45-degree field of view. 2048 by 1536 pixels. CFP: 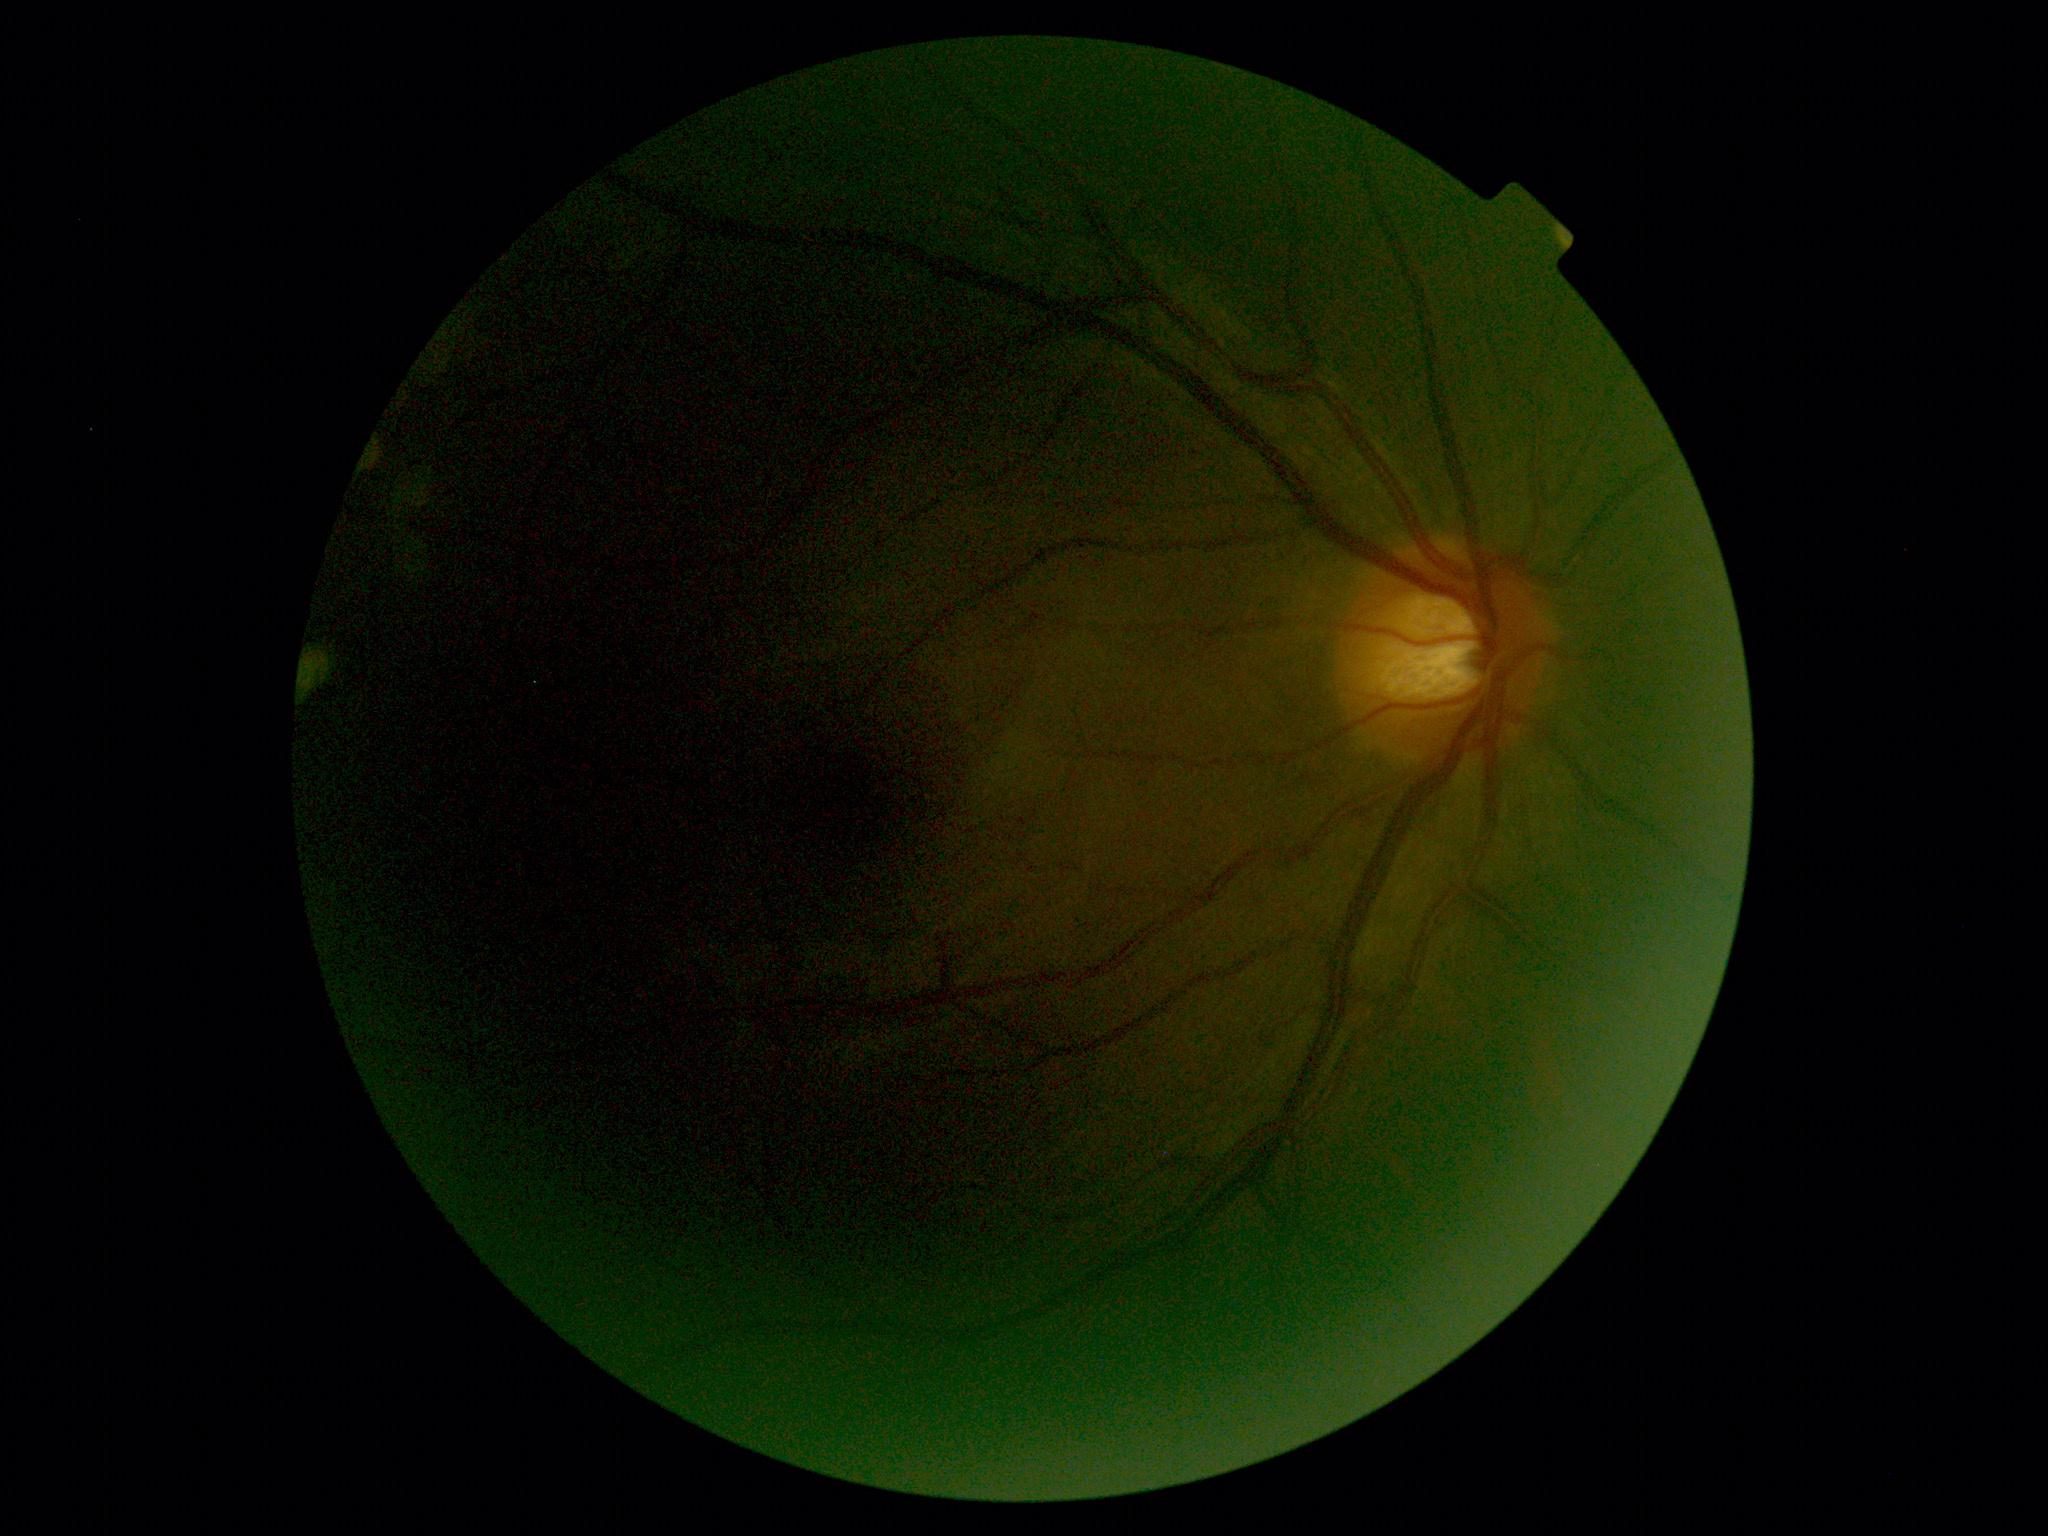

{
  "dr_grade": "ungradable",
  "quality": "insufficient"
}